Image size 1240x1240; infant wide-field retinal image; camera: Phoenix ICON (100° FOV):
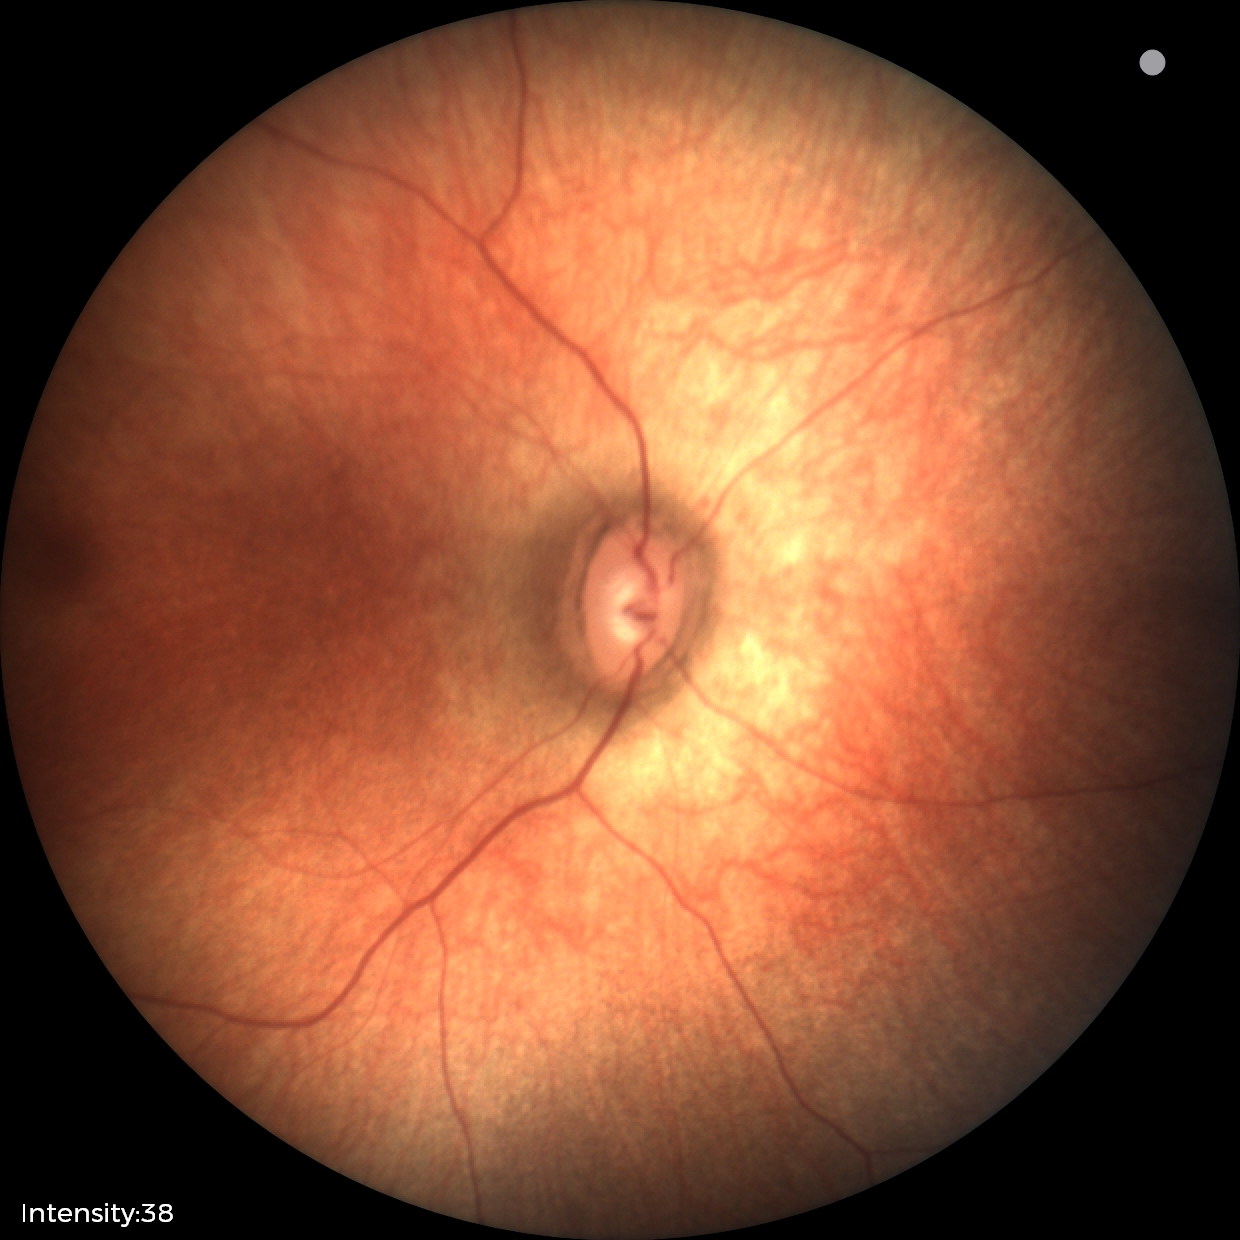
No retinal pathology identified on screening.